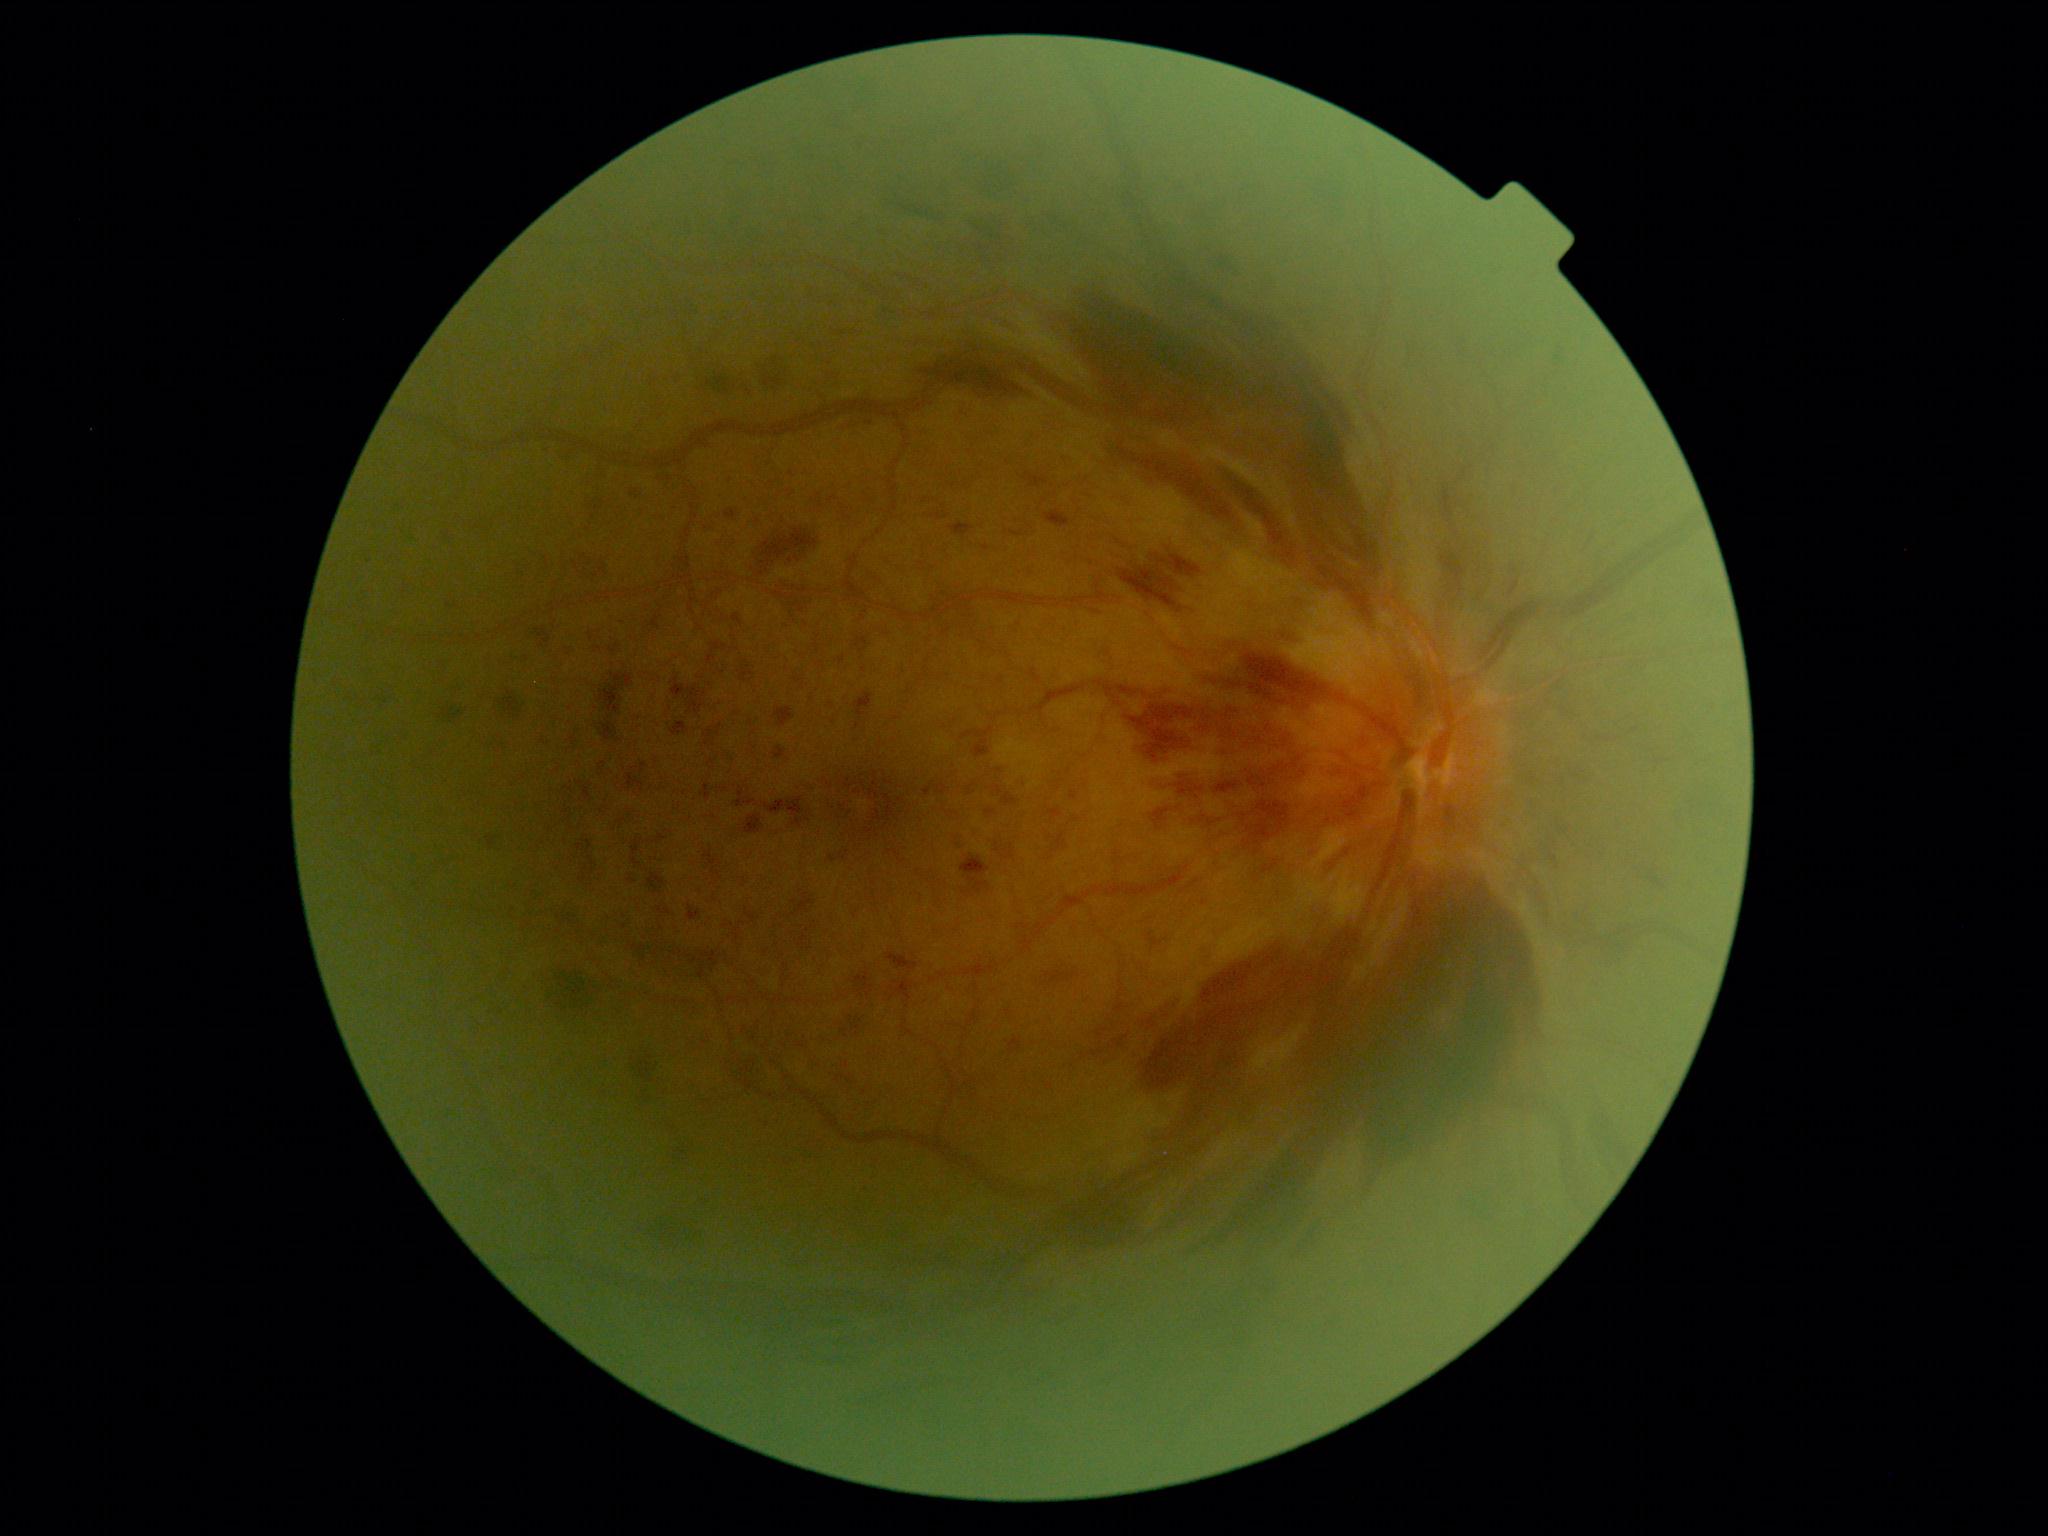 DR severity is 3/4.